CFP. 2089x1764px.
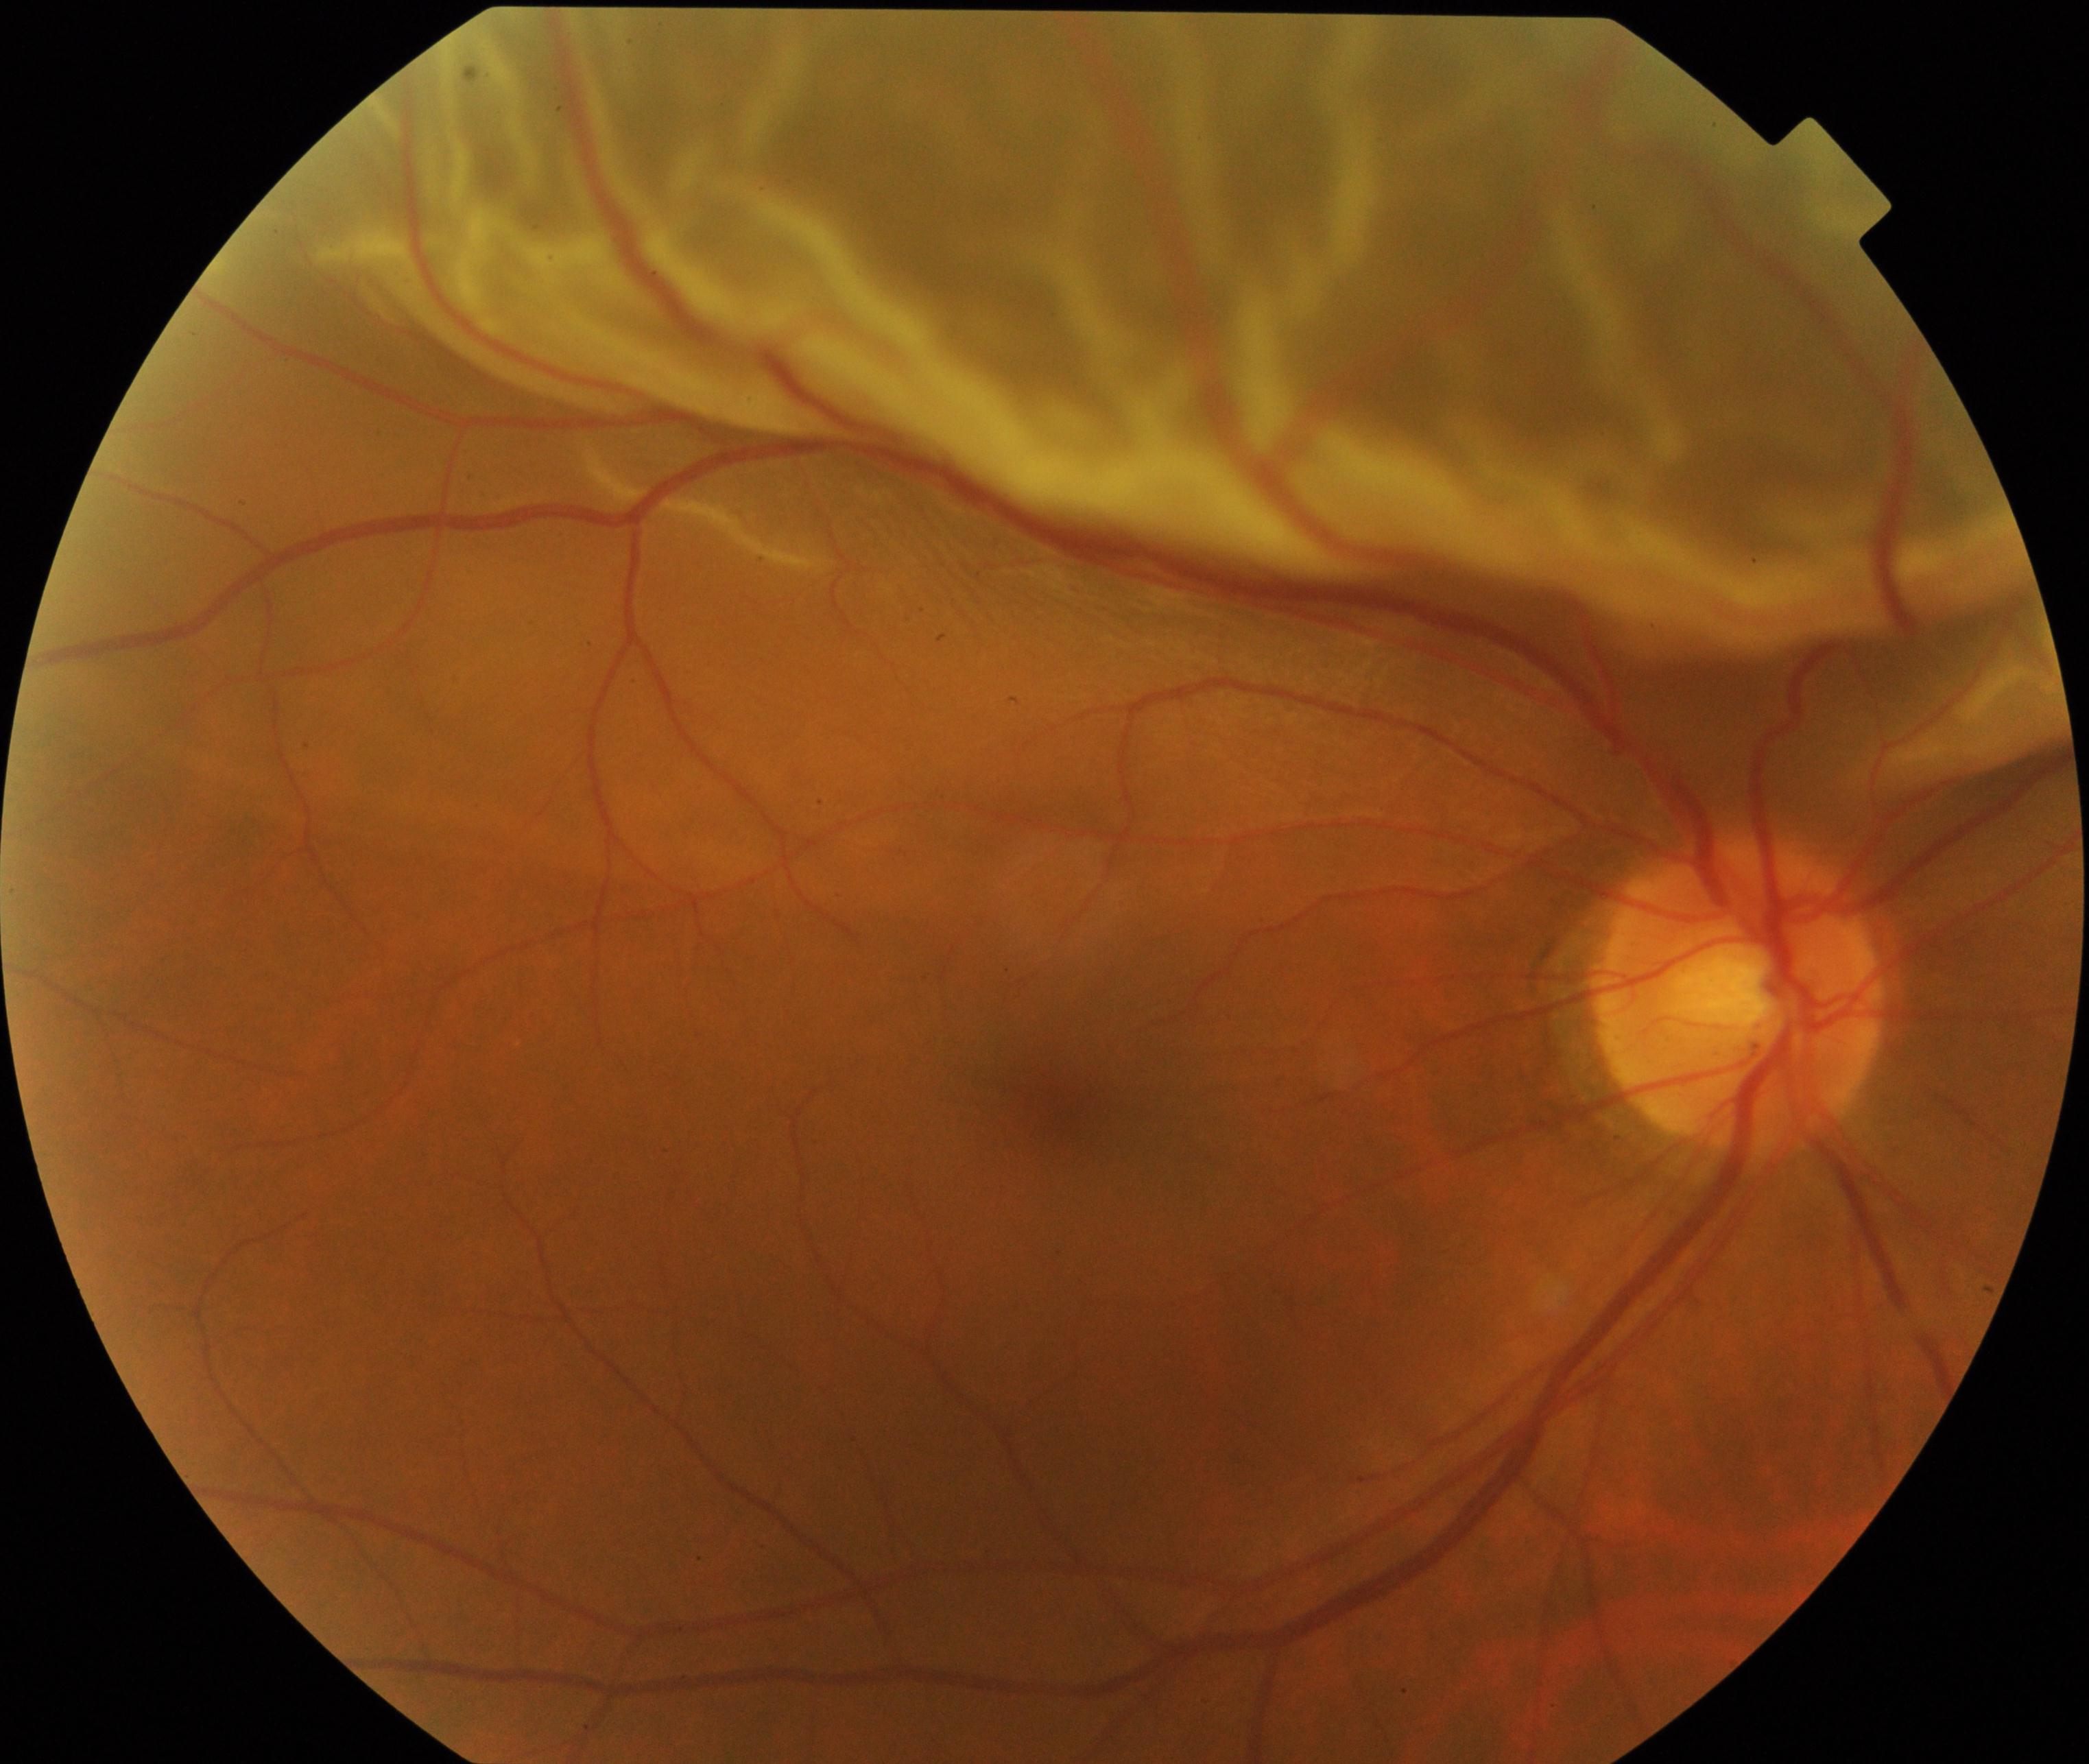

Impression: rhegmatogenous retinal detachment.